Dilated-pupil acquisition — 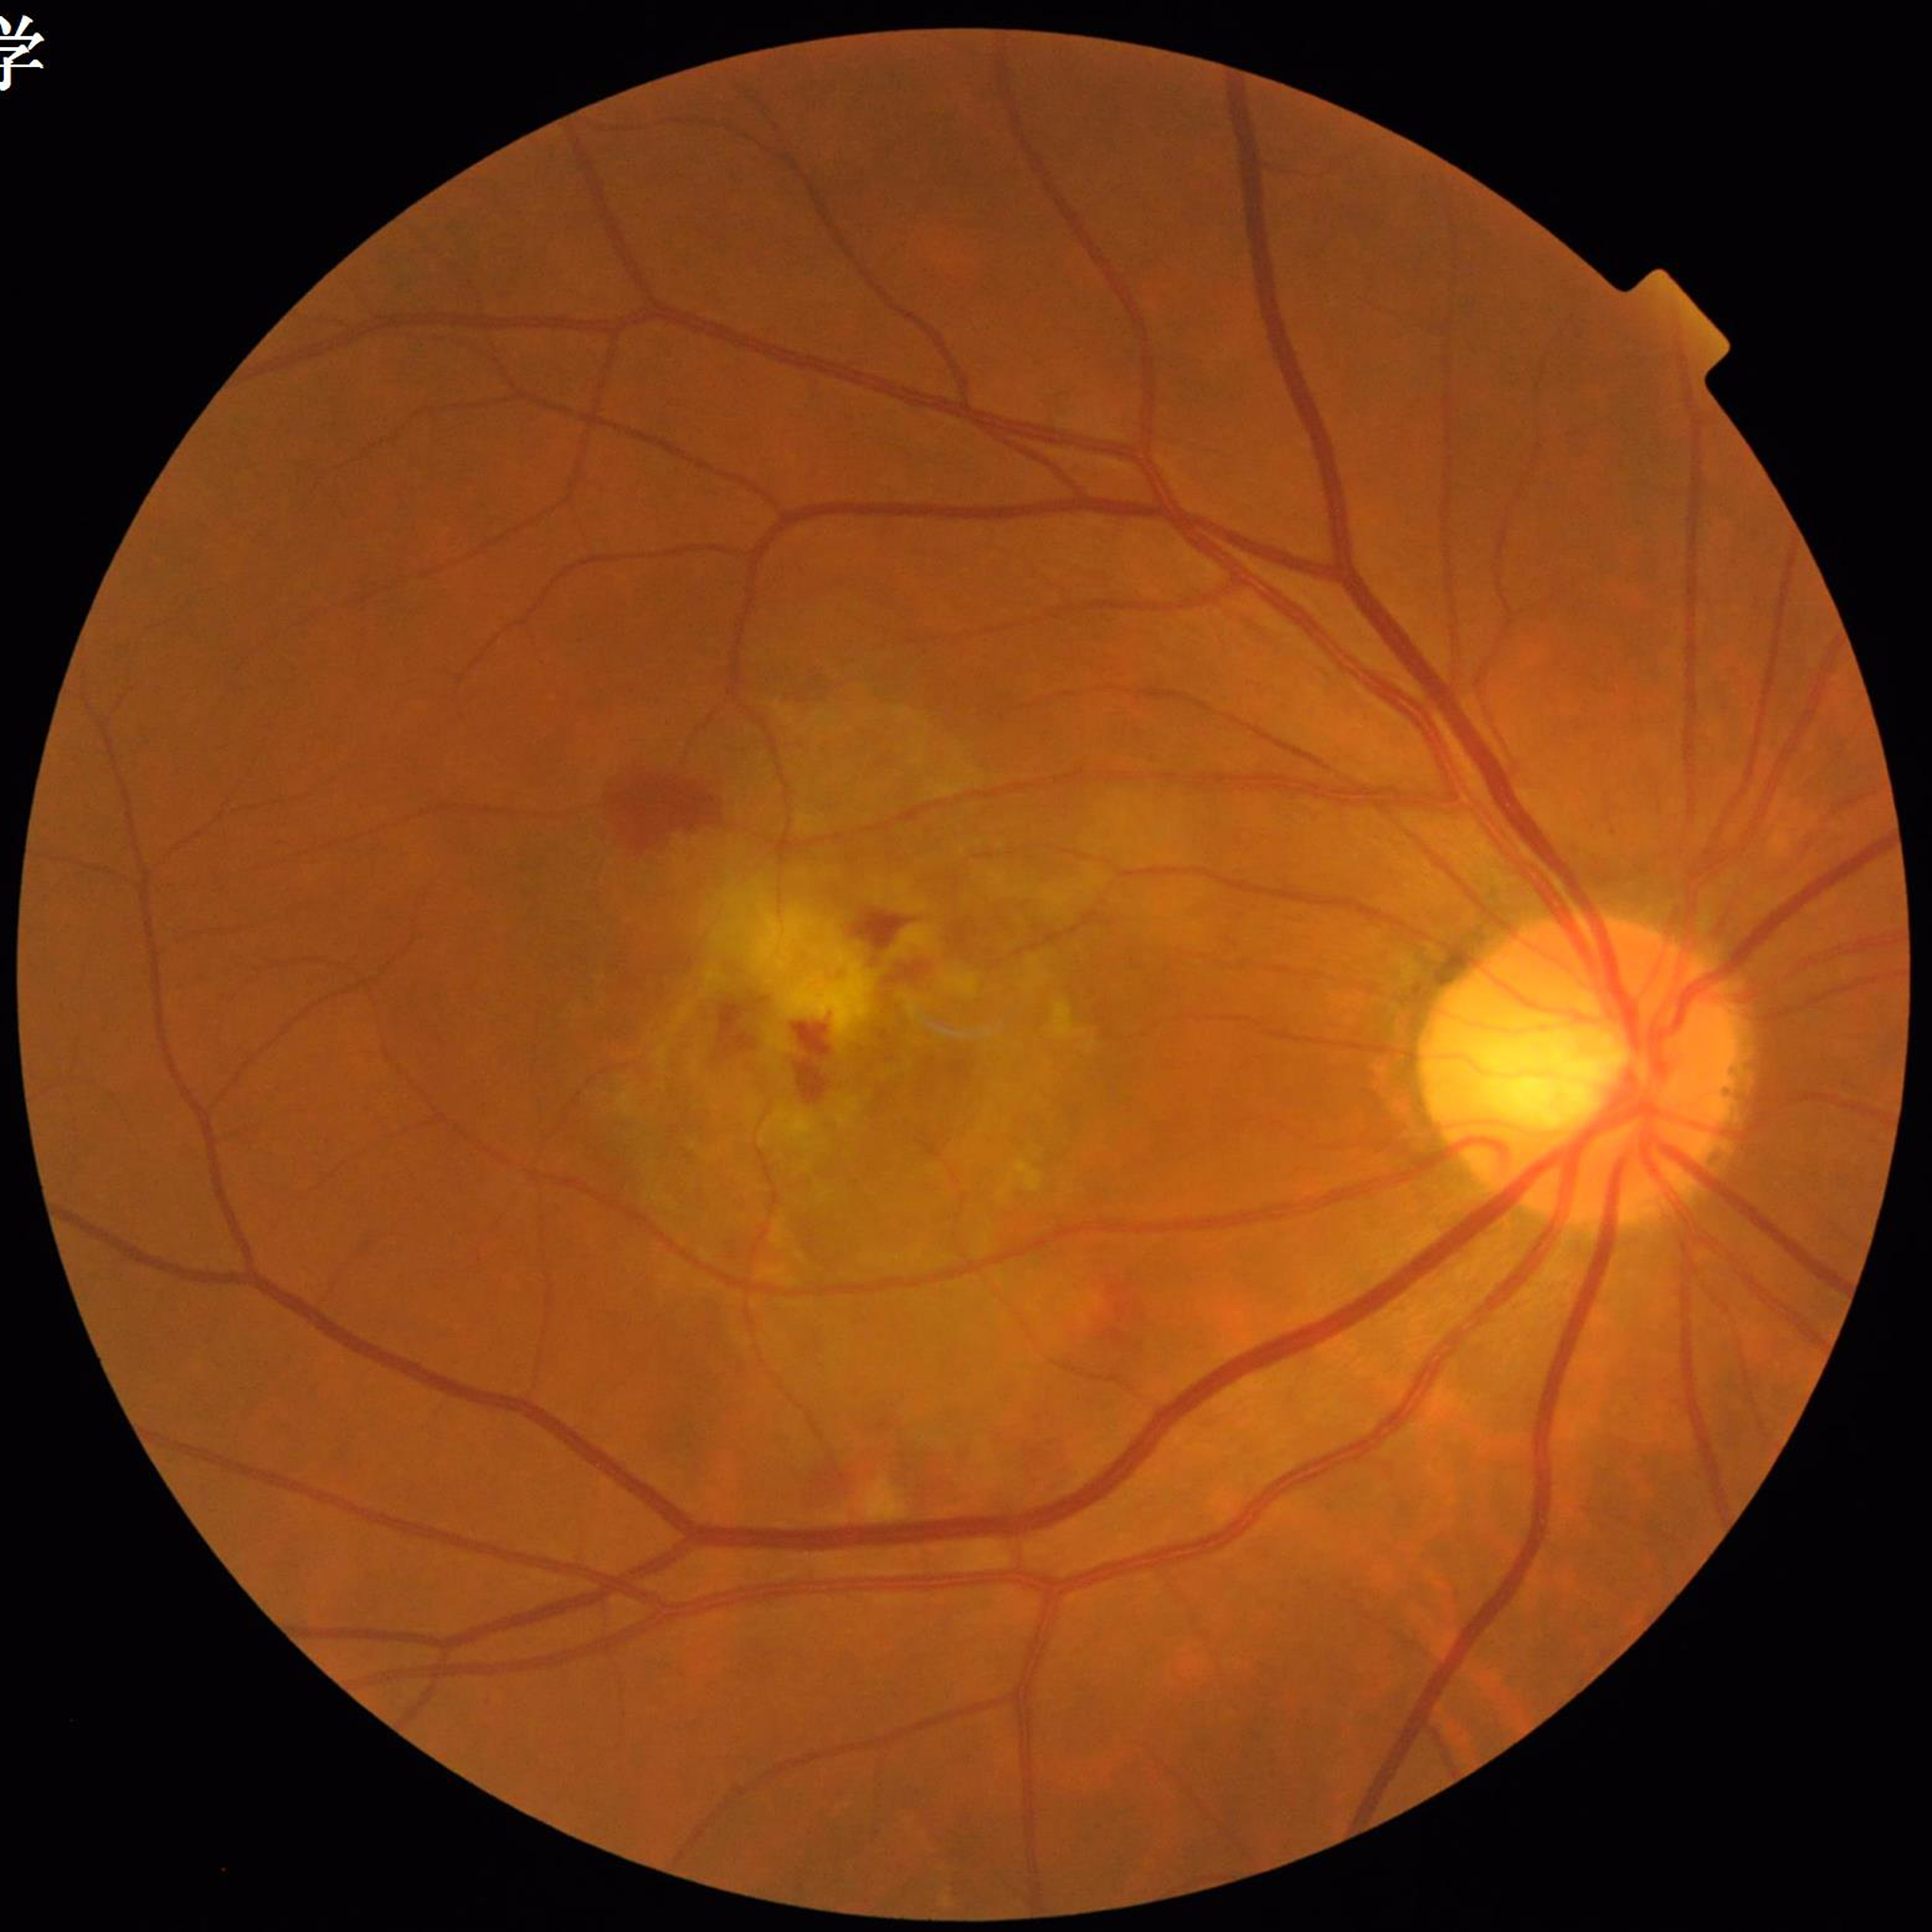

Eye affected by age-related macular degeneration.